100° field of view (Phoenix ICON) · 1240 by 1240 pixels · wide-field fundus photograph from neonatal ROP screening.
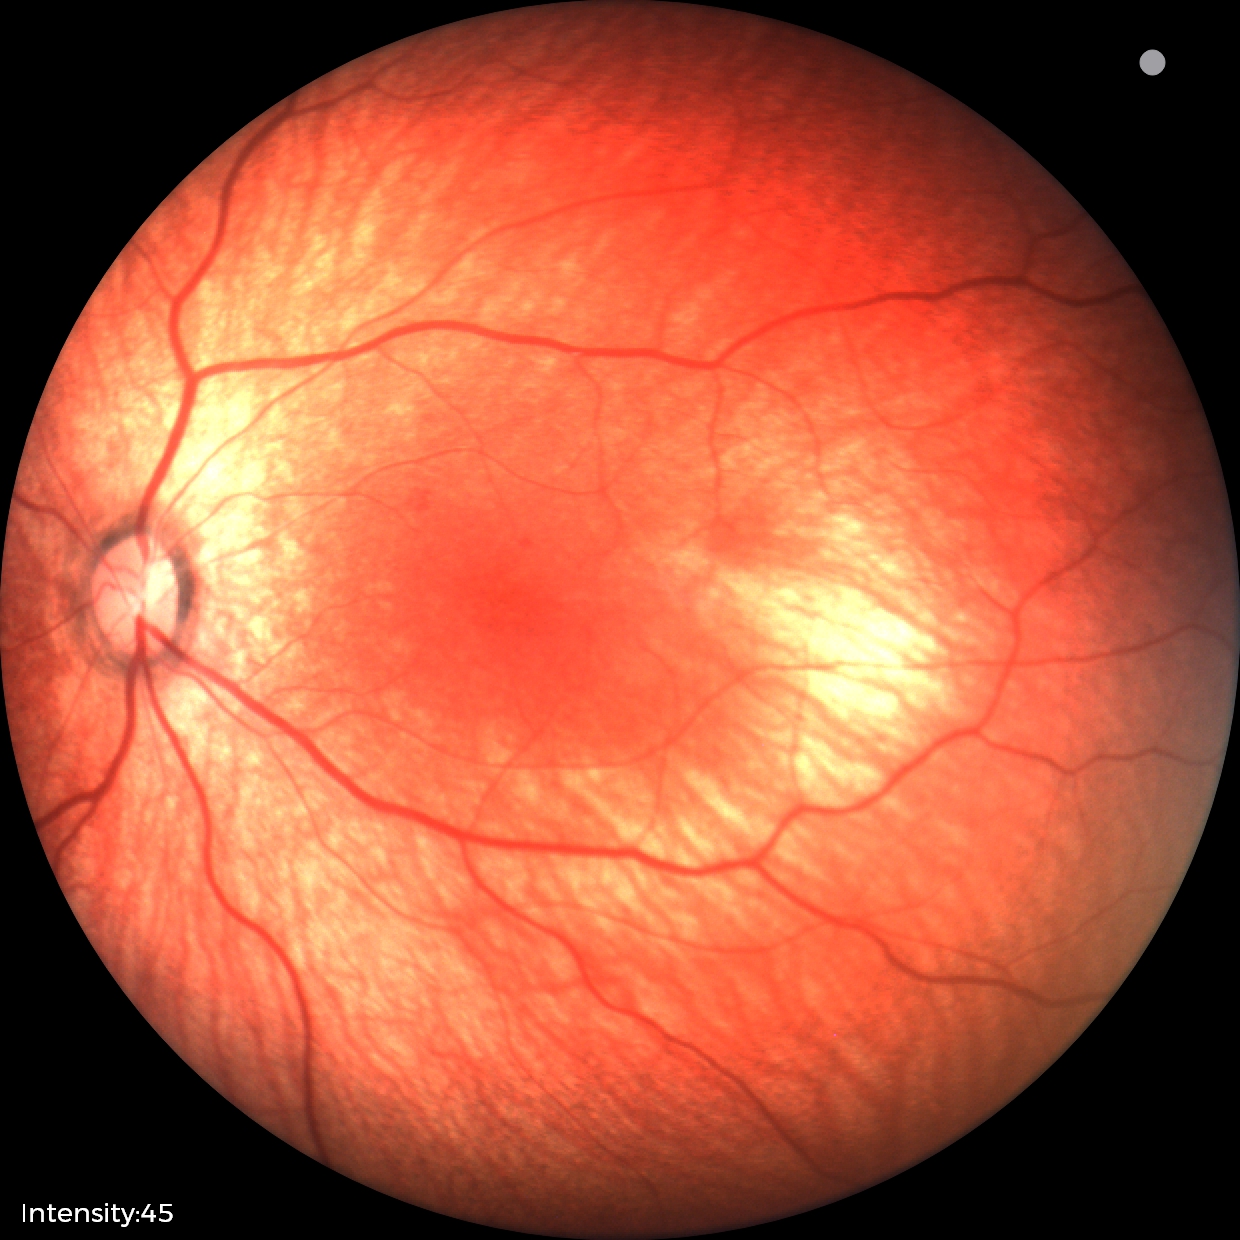

Assessment: normal retinal appearance.